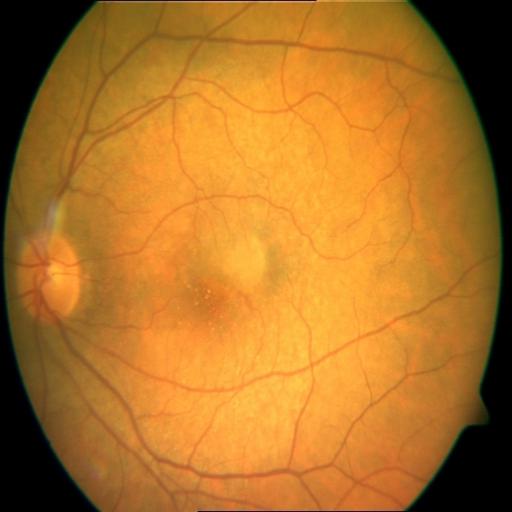
Pathology:
- chorioretinitis